Davis DR grading
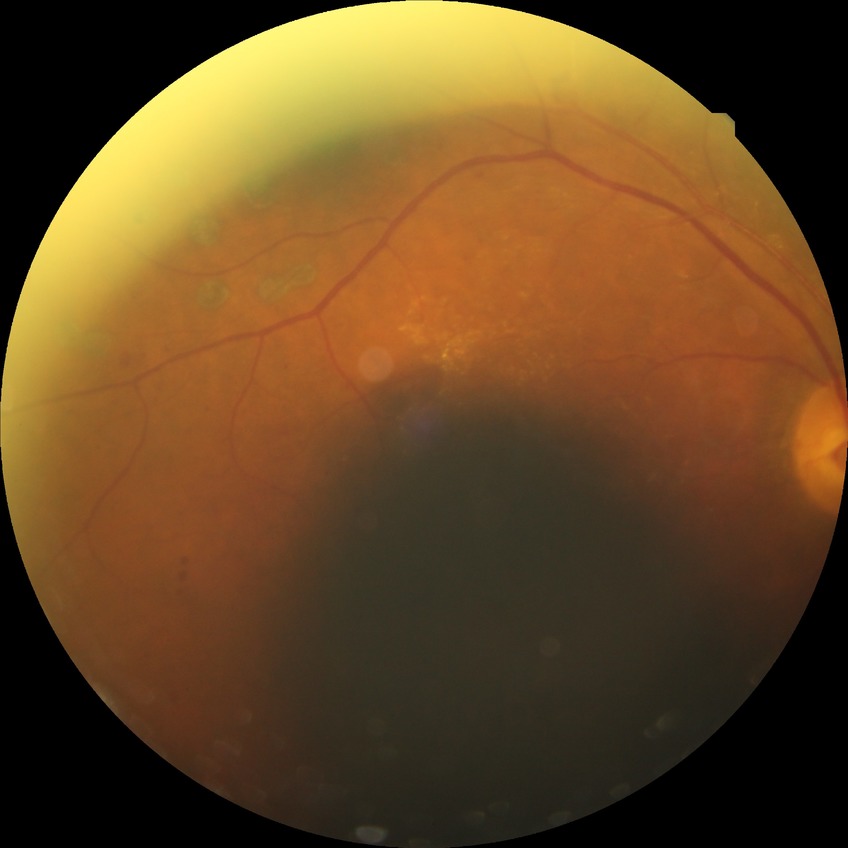 Diabetic retinopathy stage: proliferative diabetic retinopathy.